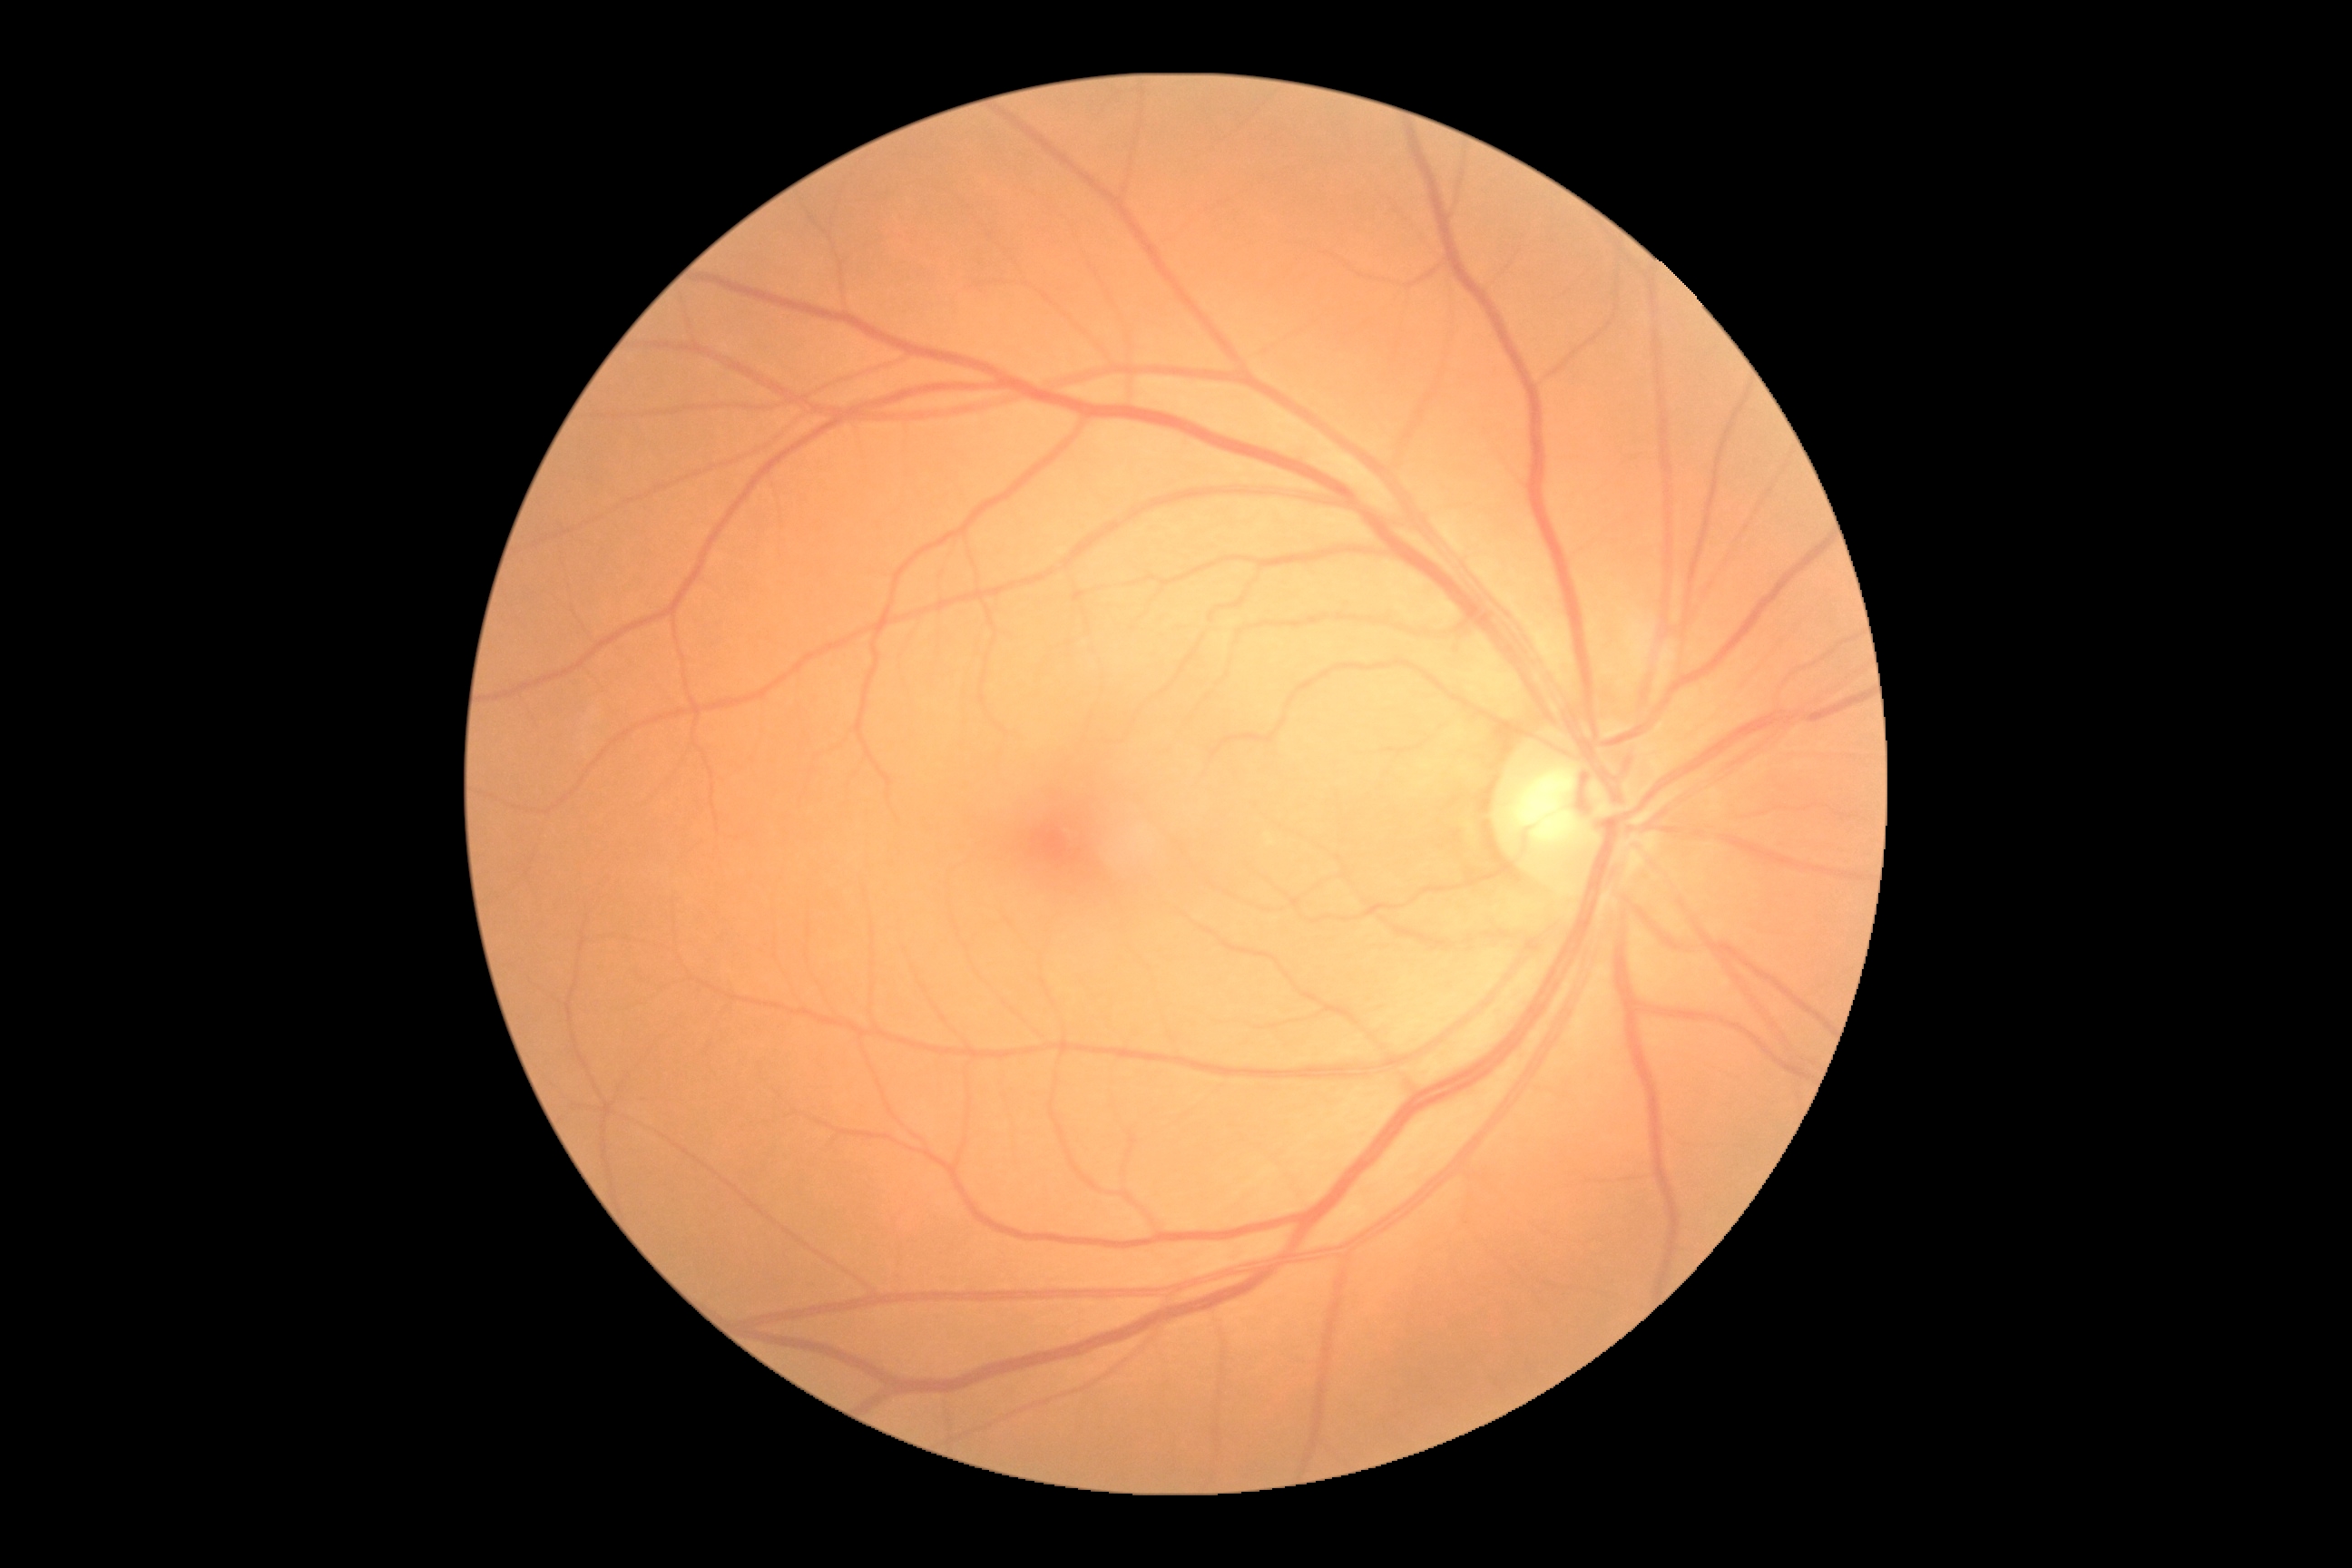

diabetic retinopathy@0.